640 by 480 pixels · RetCam wide-field infant fundus image.
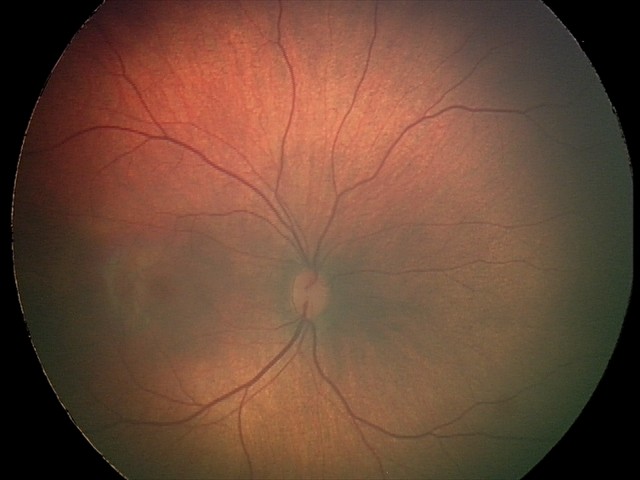
Examination diagnosed as retinal hemorrhages.